2352 by 1568 pixels.
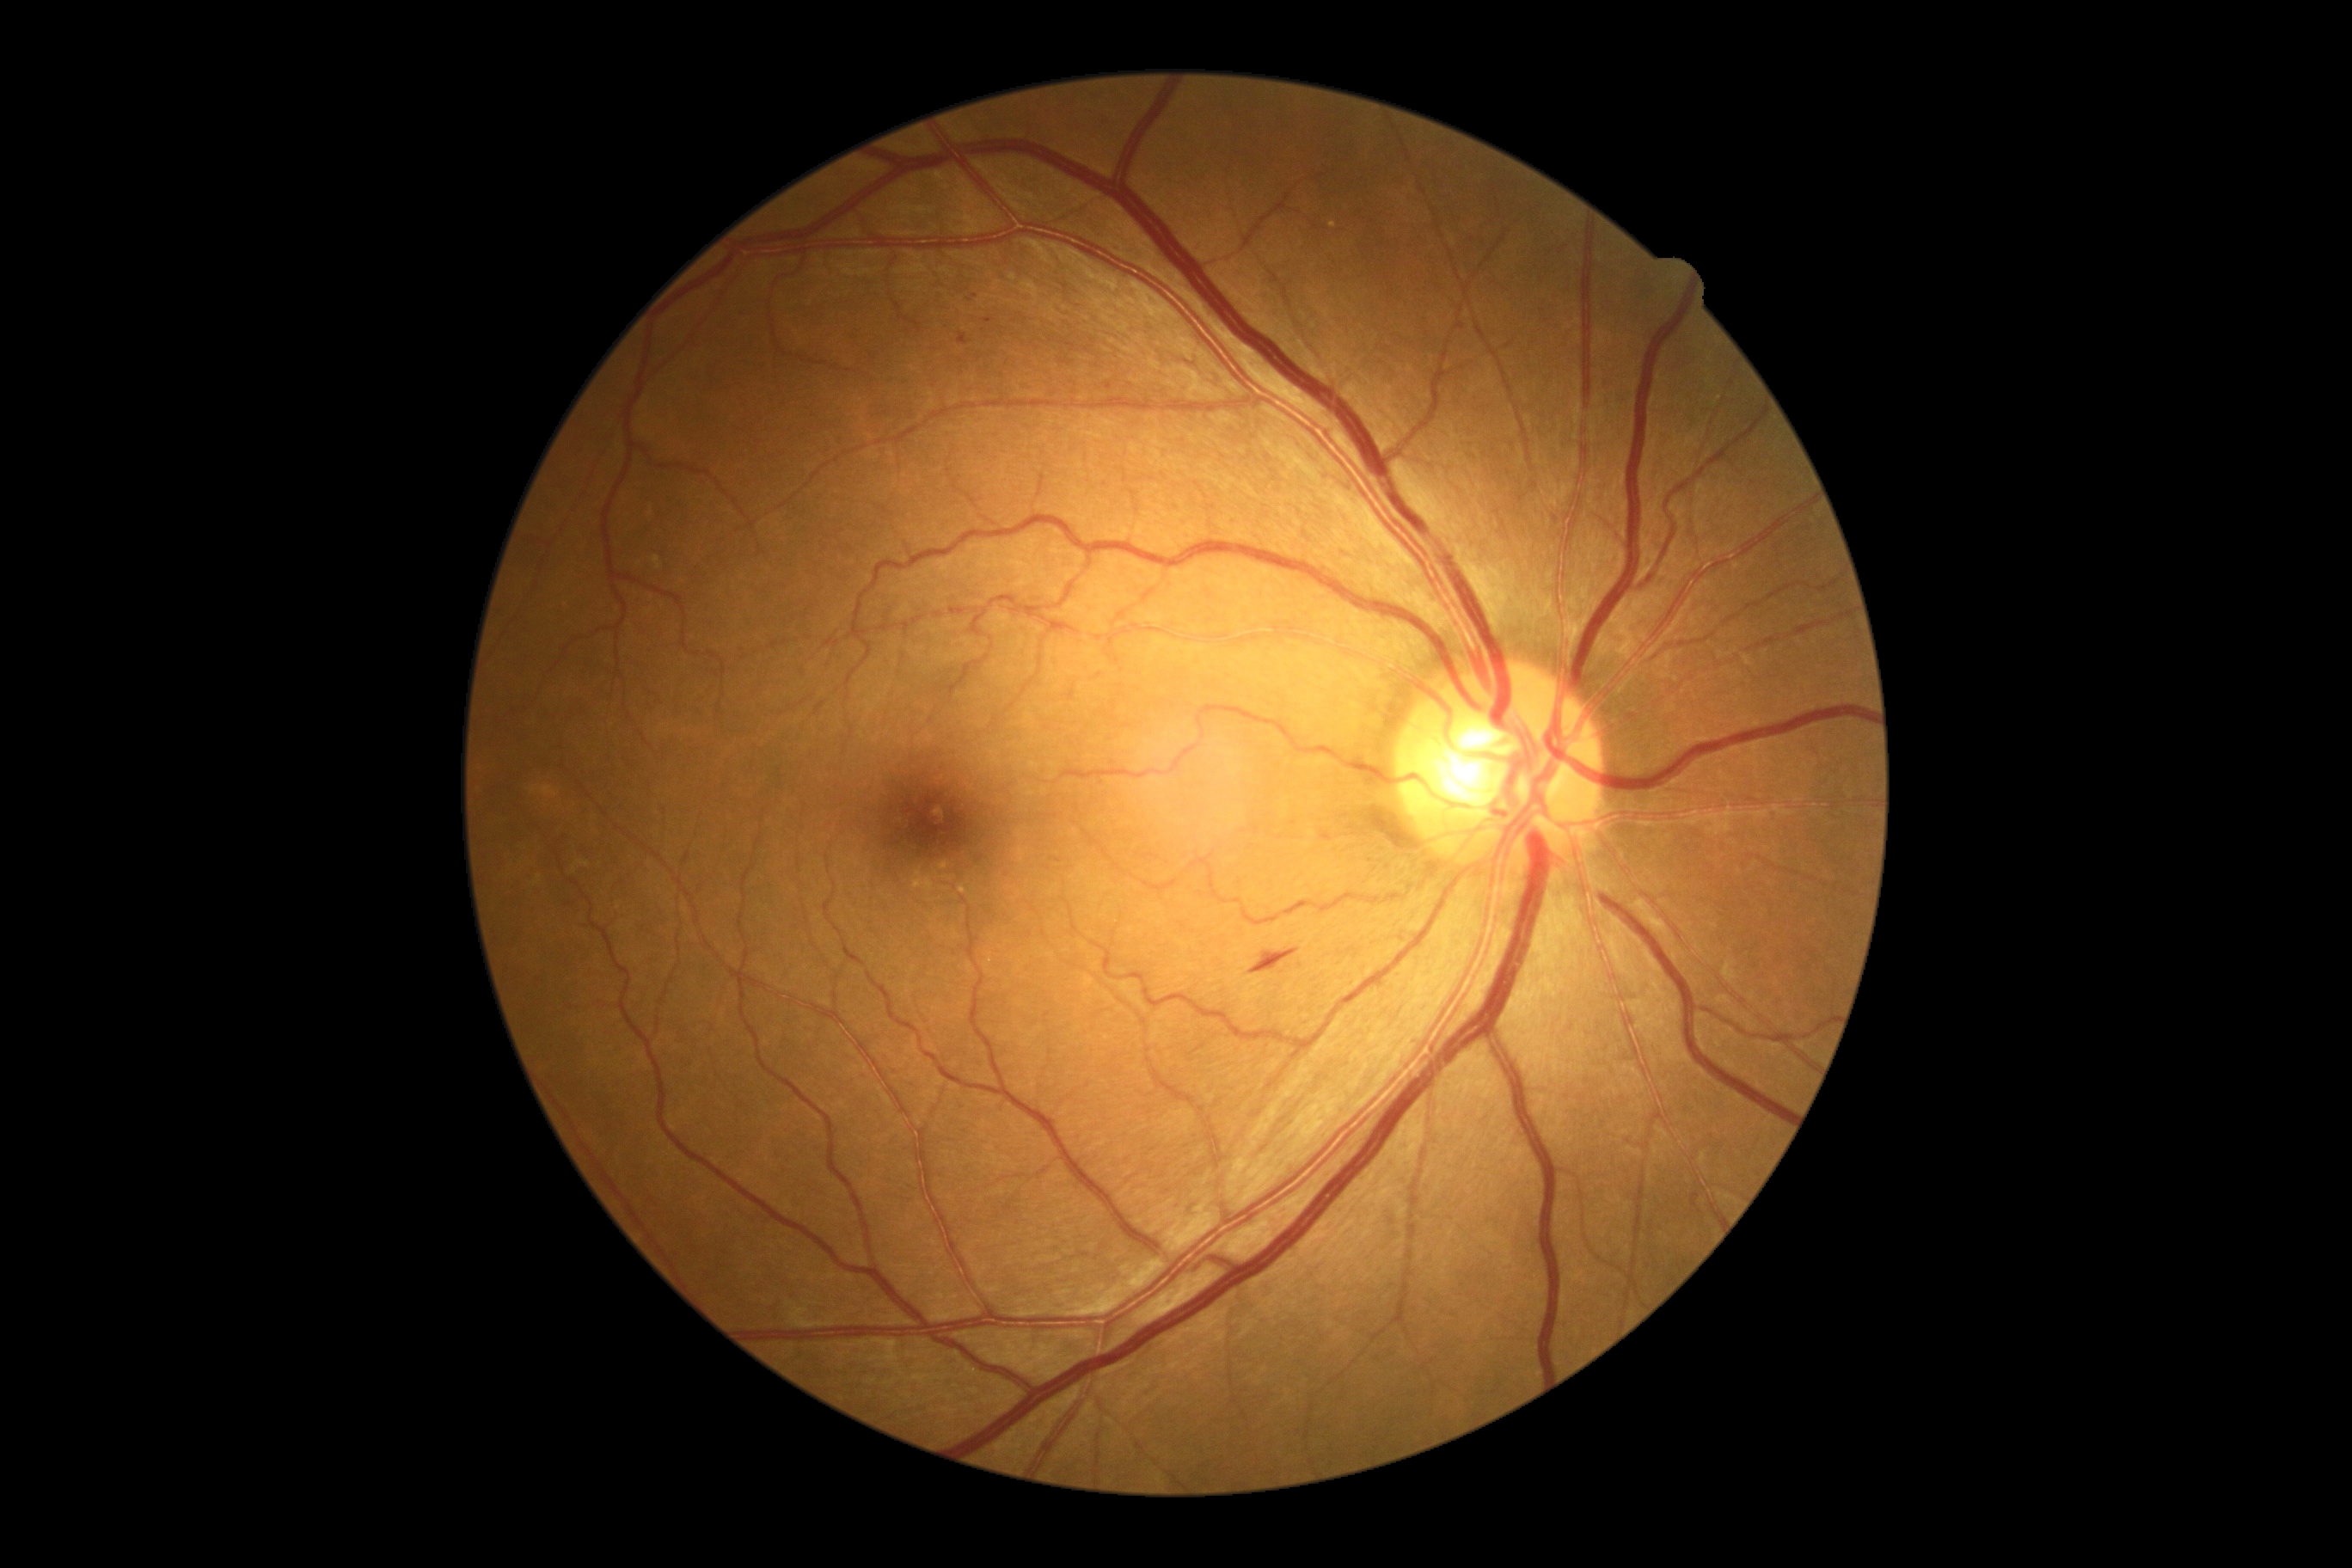 Diabetic retinopathy severity is grade 2.